Infant wide-field fundus photograph. 100° field of view (Phoenix ICON):
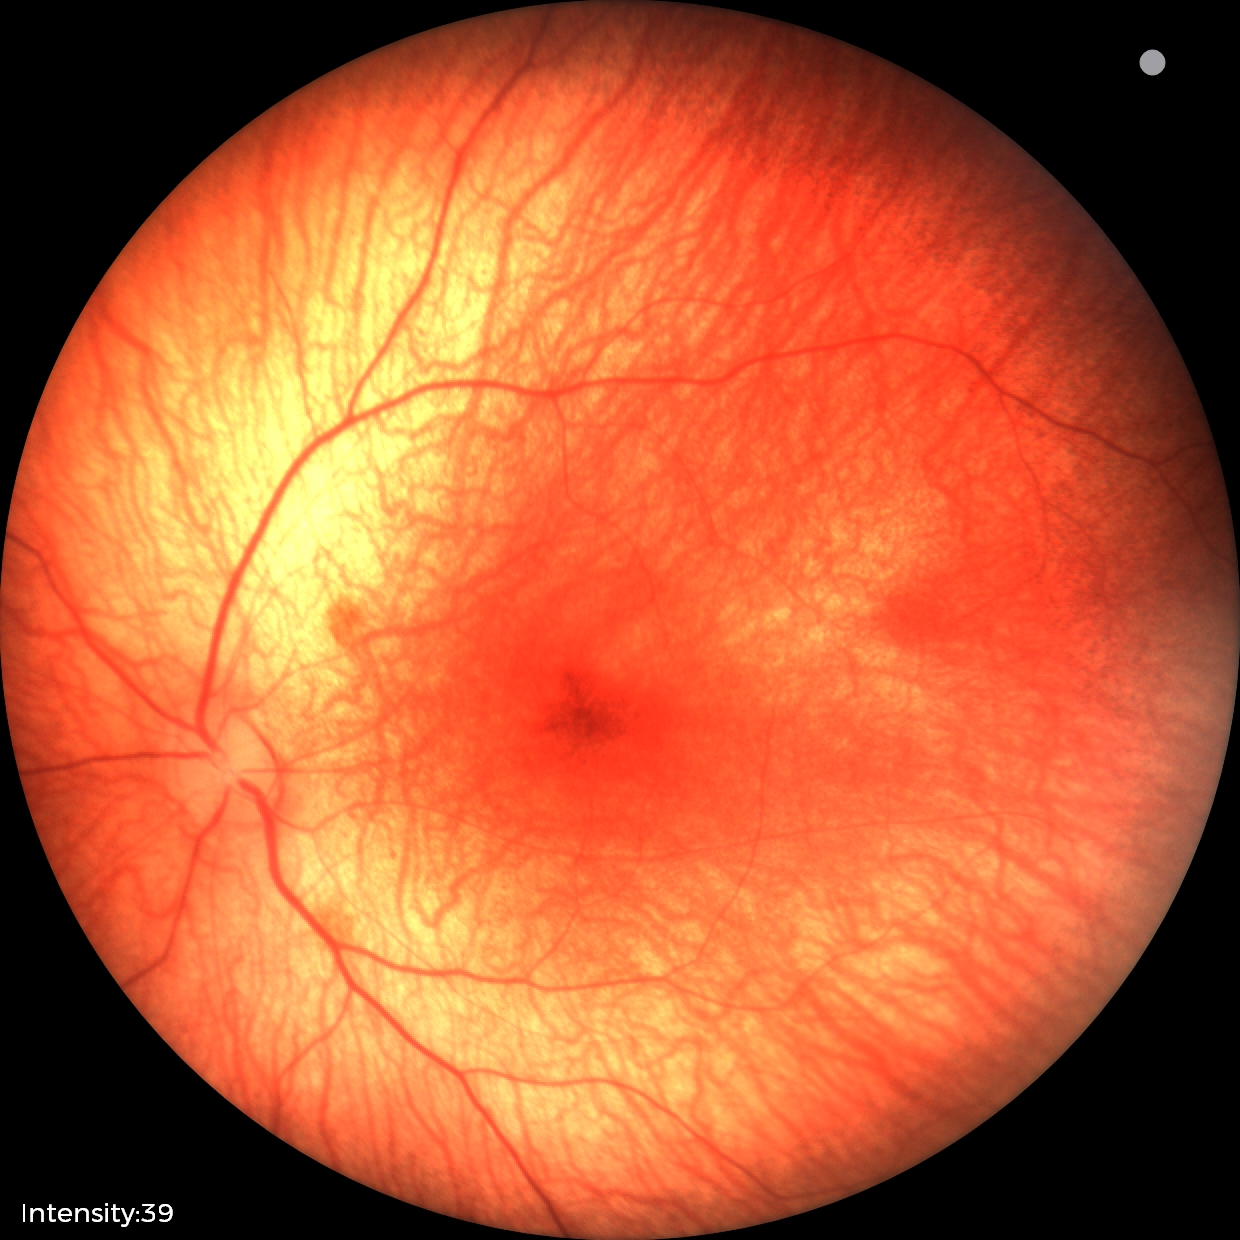 Series diagnosed as retinal hemorrhages.